Fundus photo; image size 2352x1568: 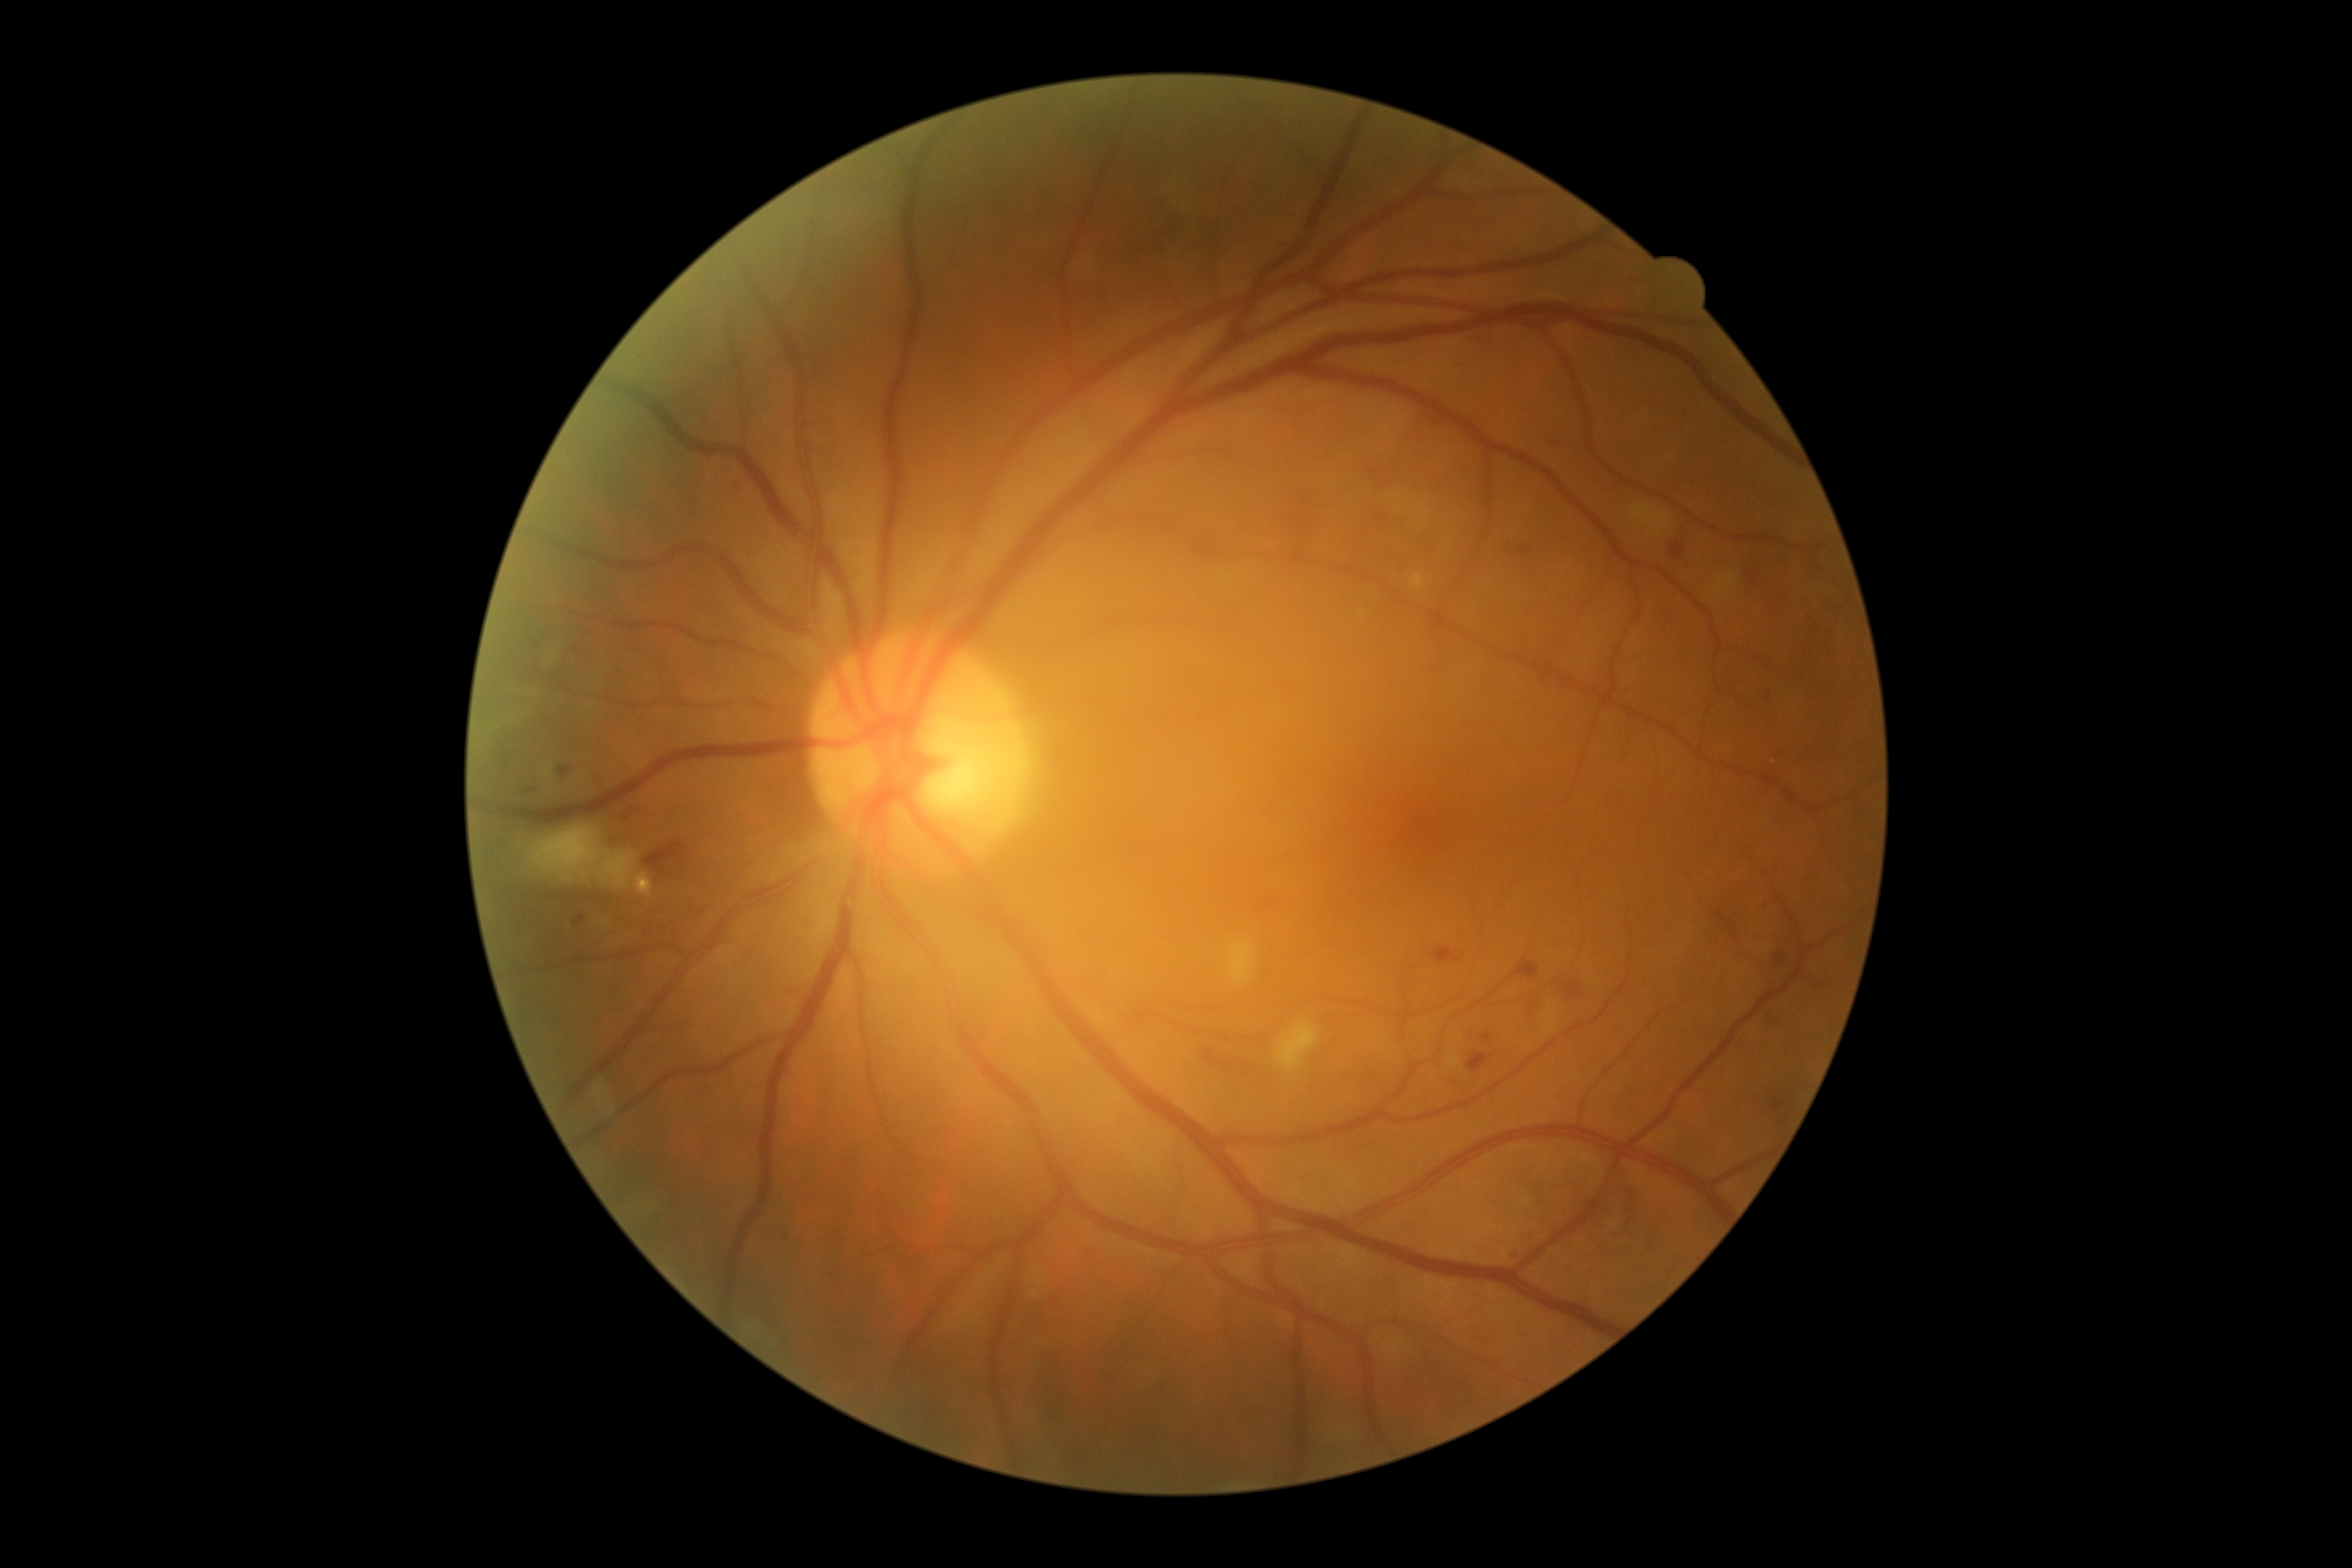
DR stage: grade 2 (moderate NPDR)